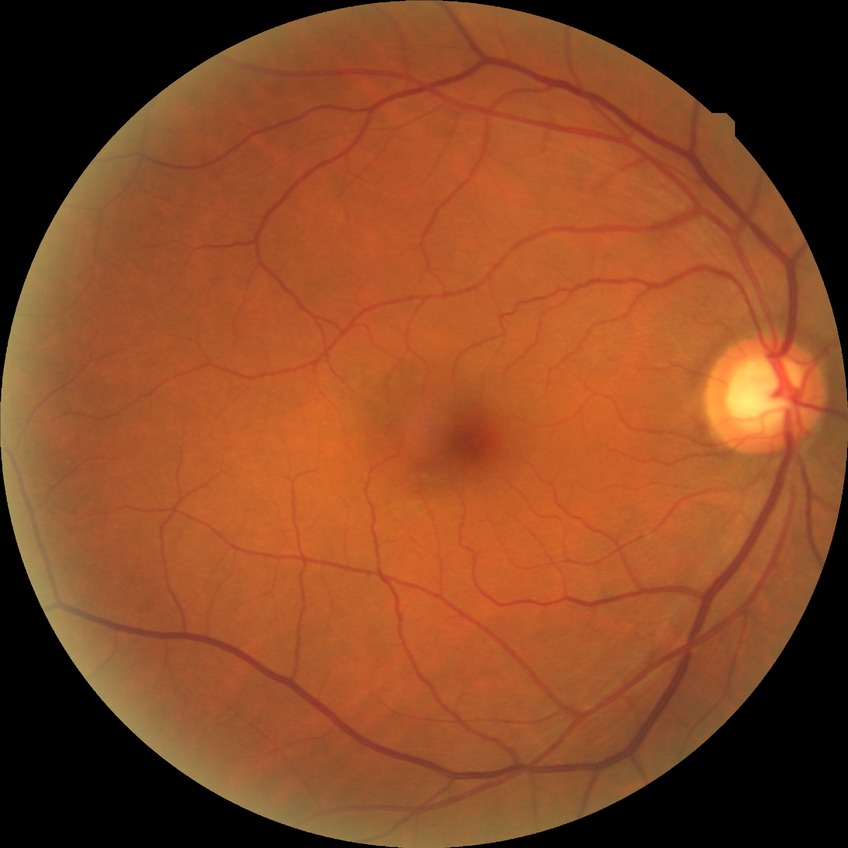

Davis grade is NDR.